FOV: 45 degrees. 1470x1137px. Fundus photo:
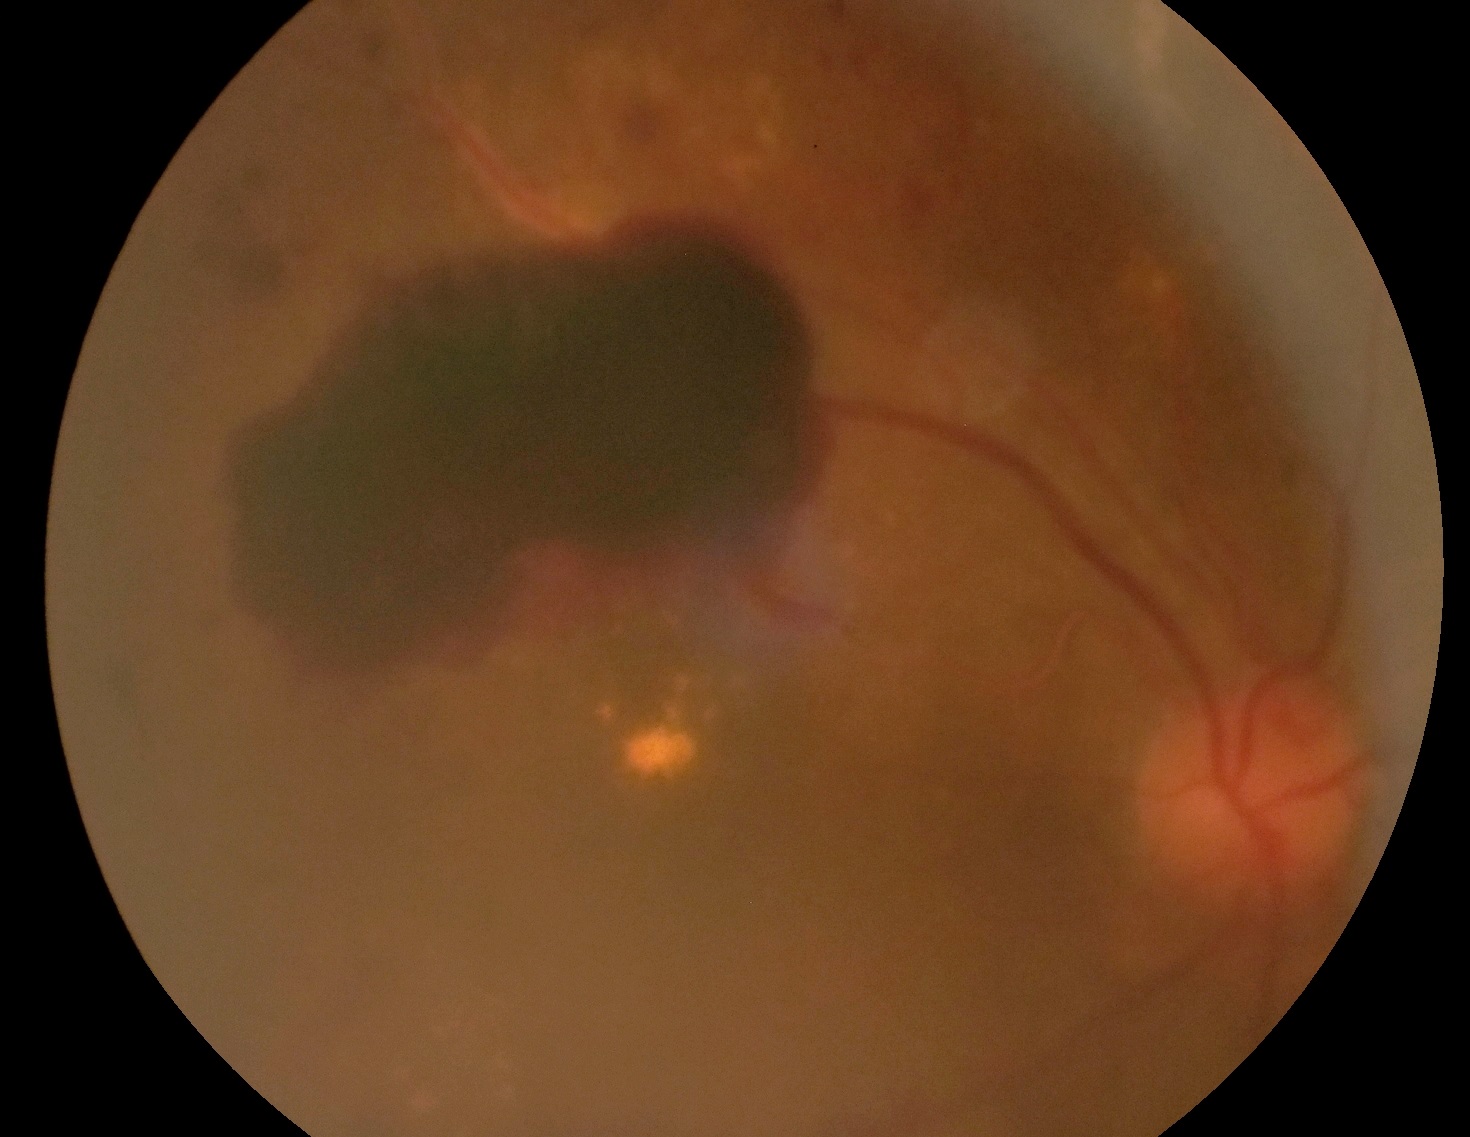
  dr_grade: grade 4 — neovascularization and/or vitreous/pre-retinal hemorrhage